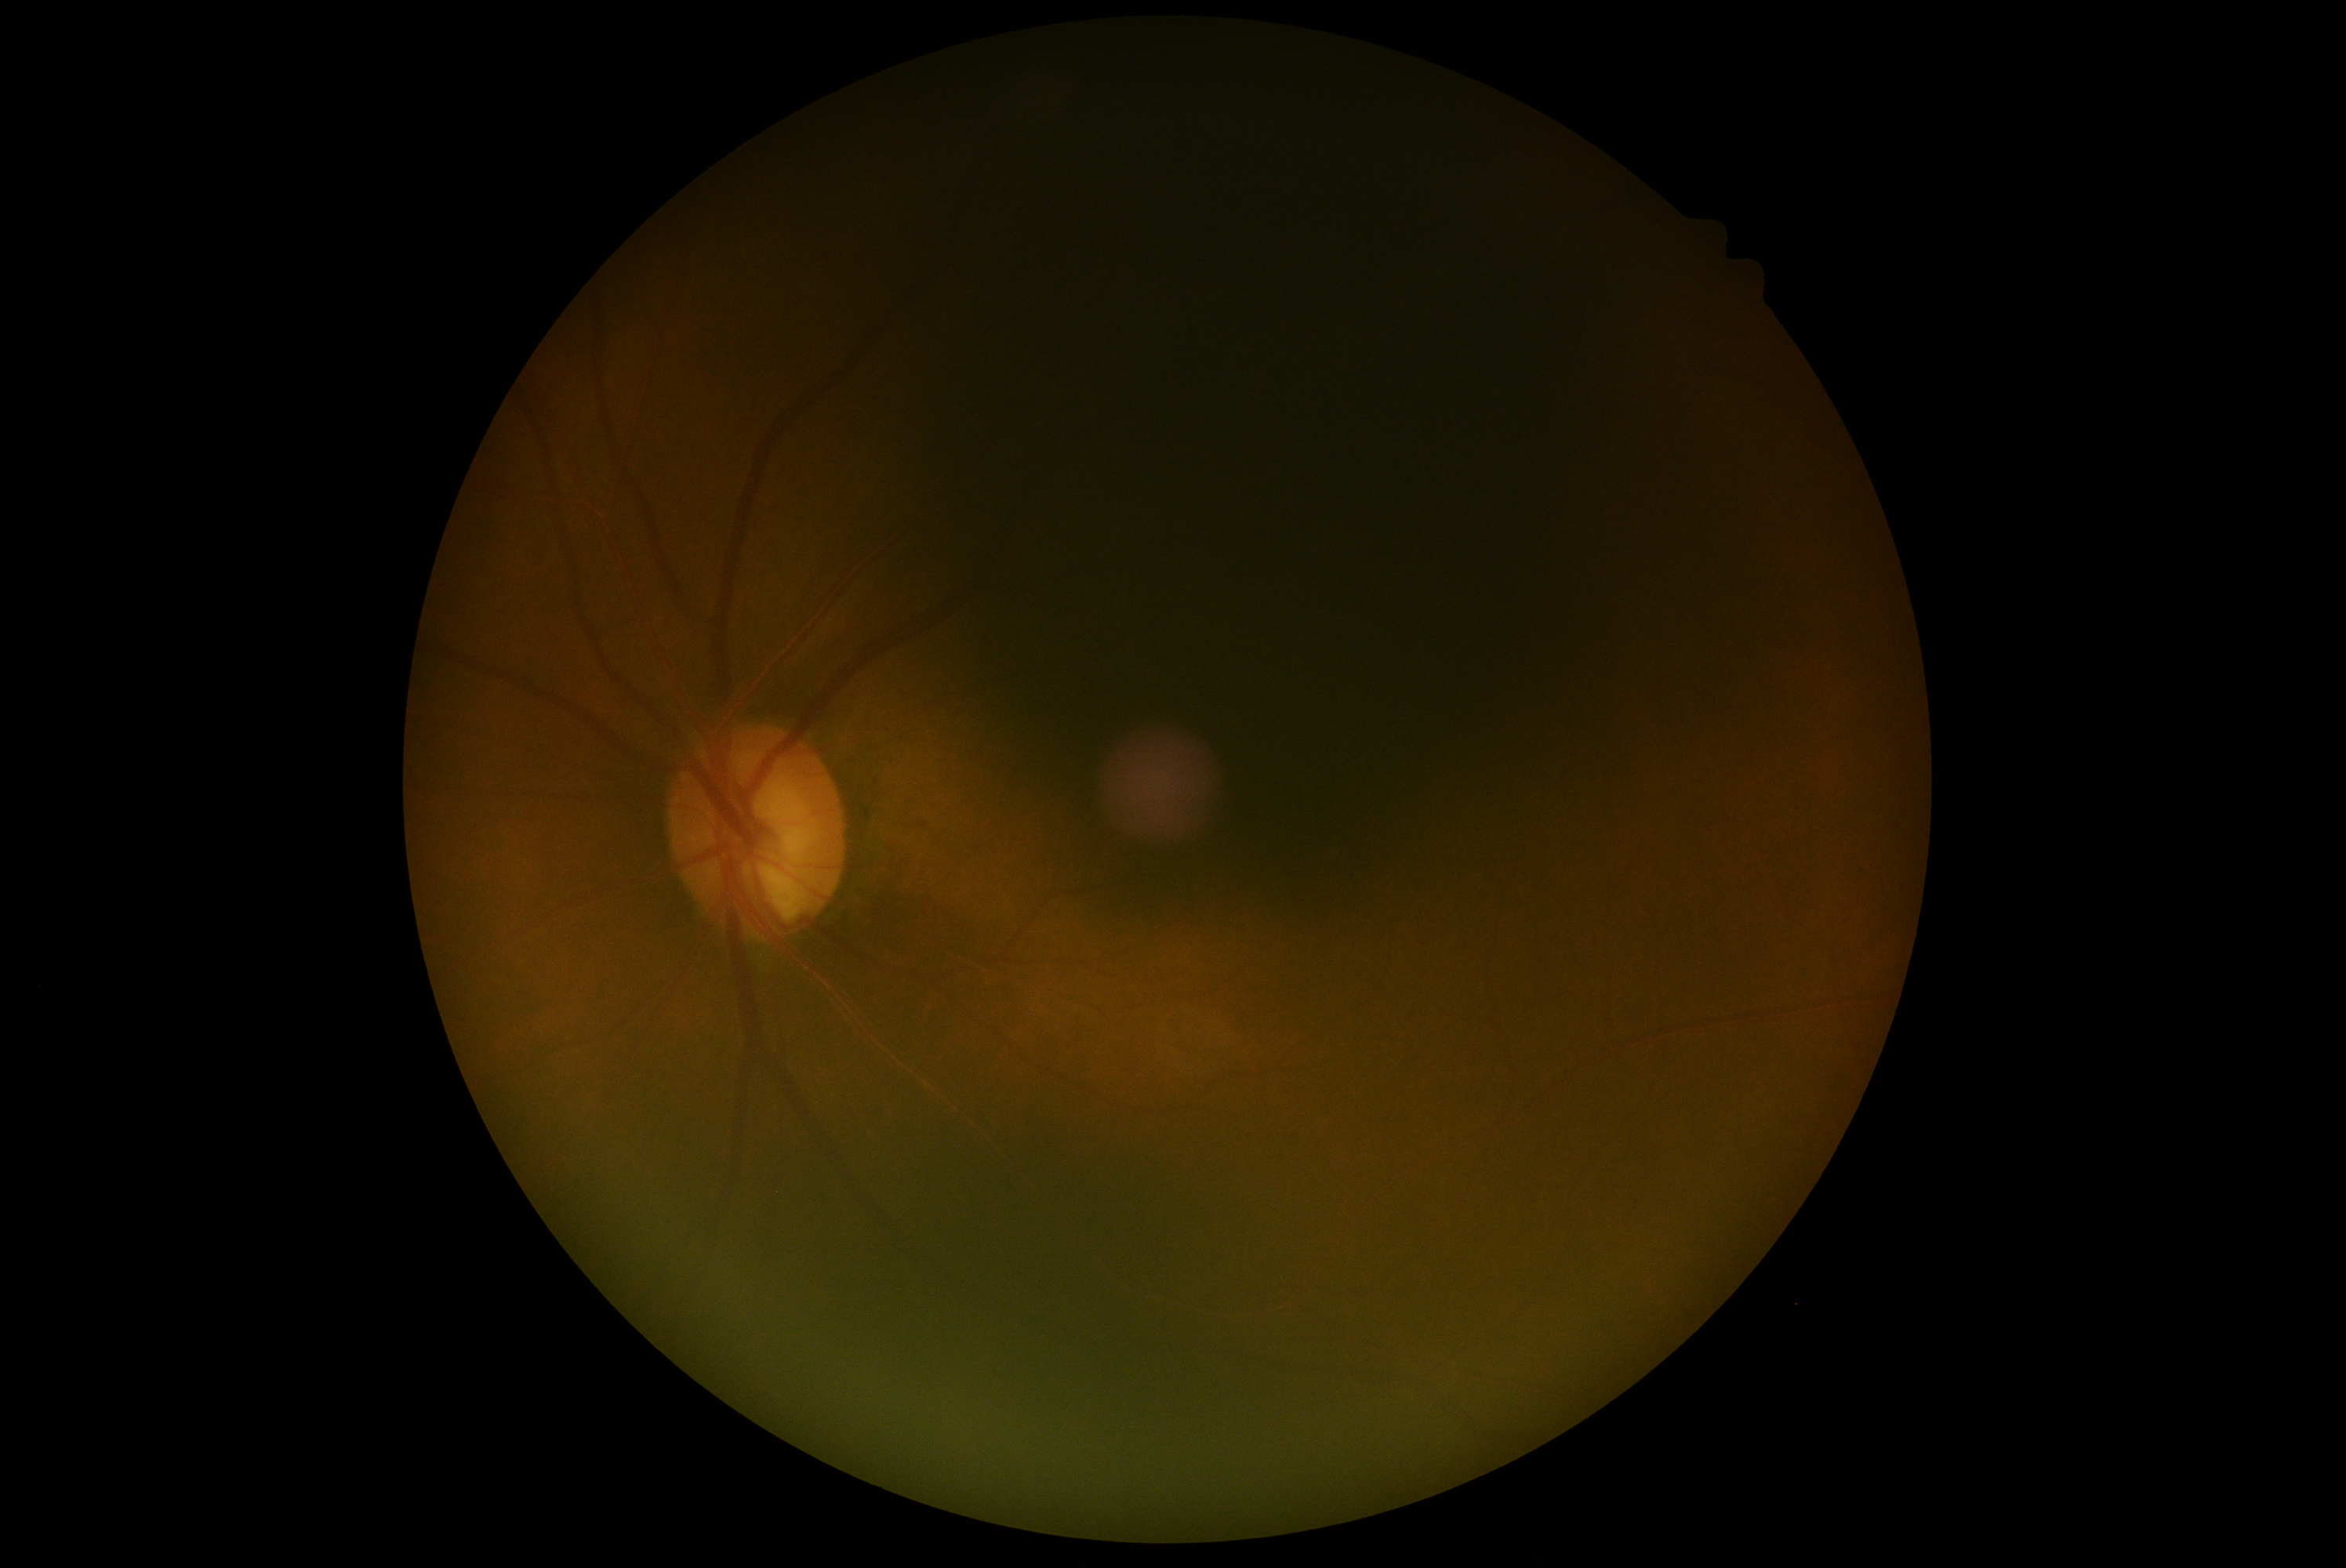
DR stage: 0/4.